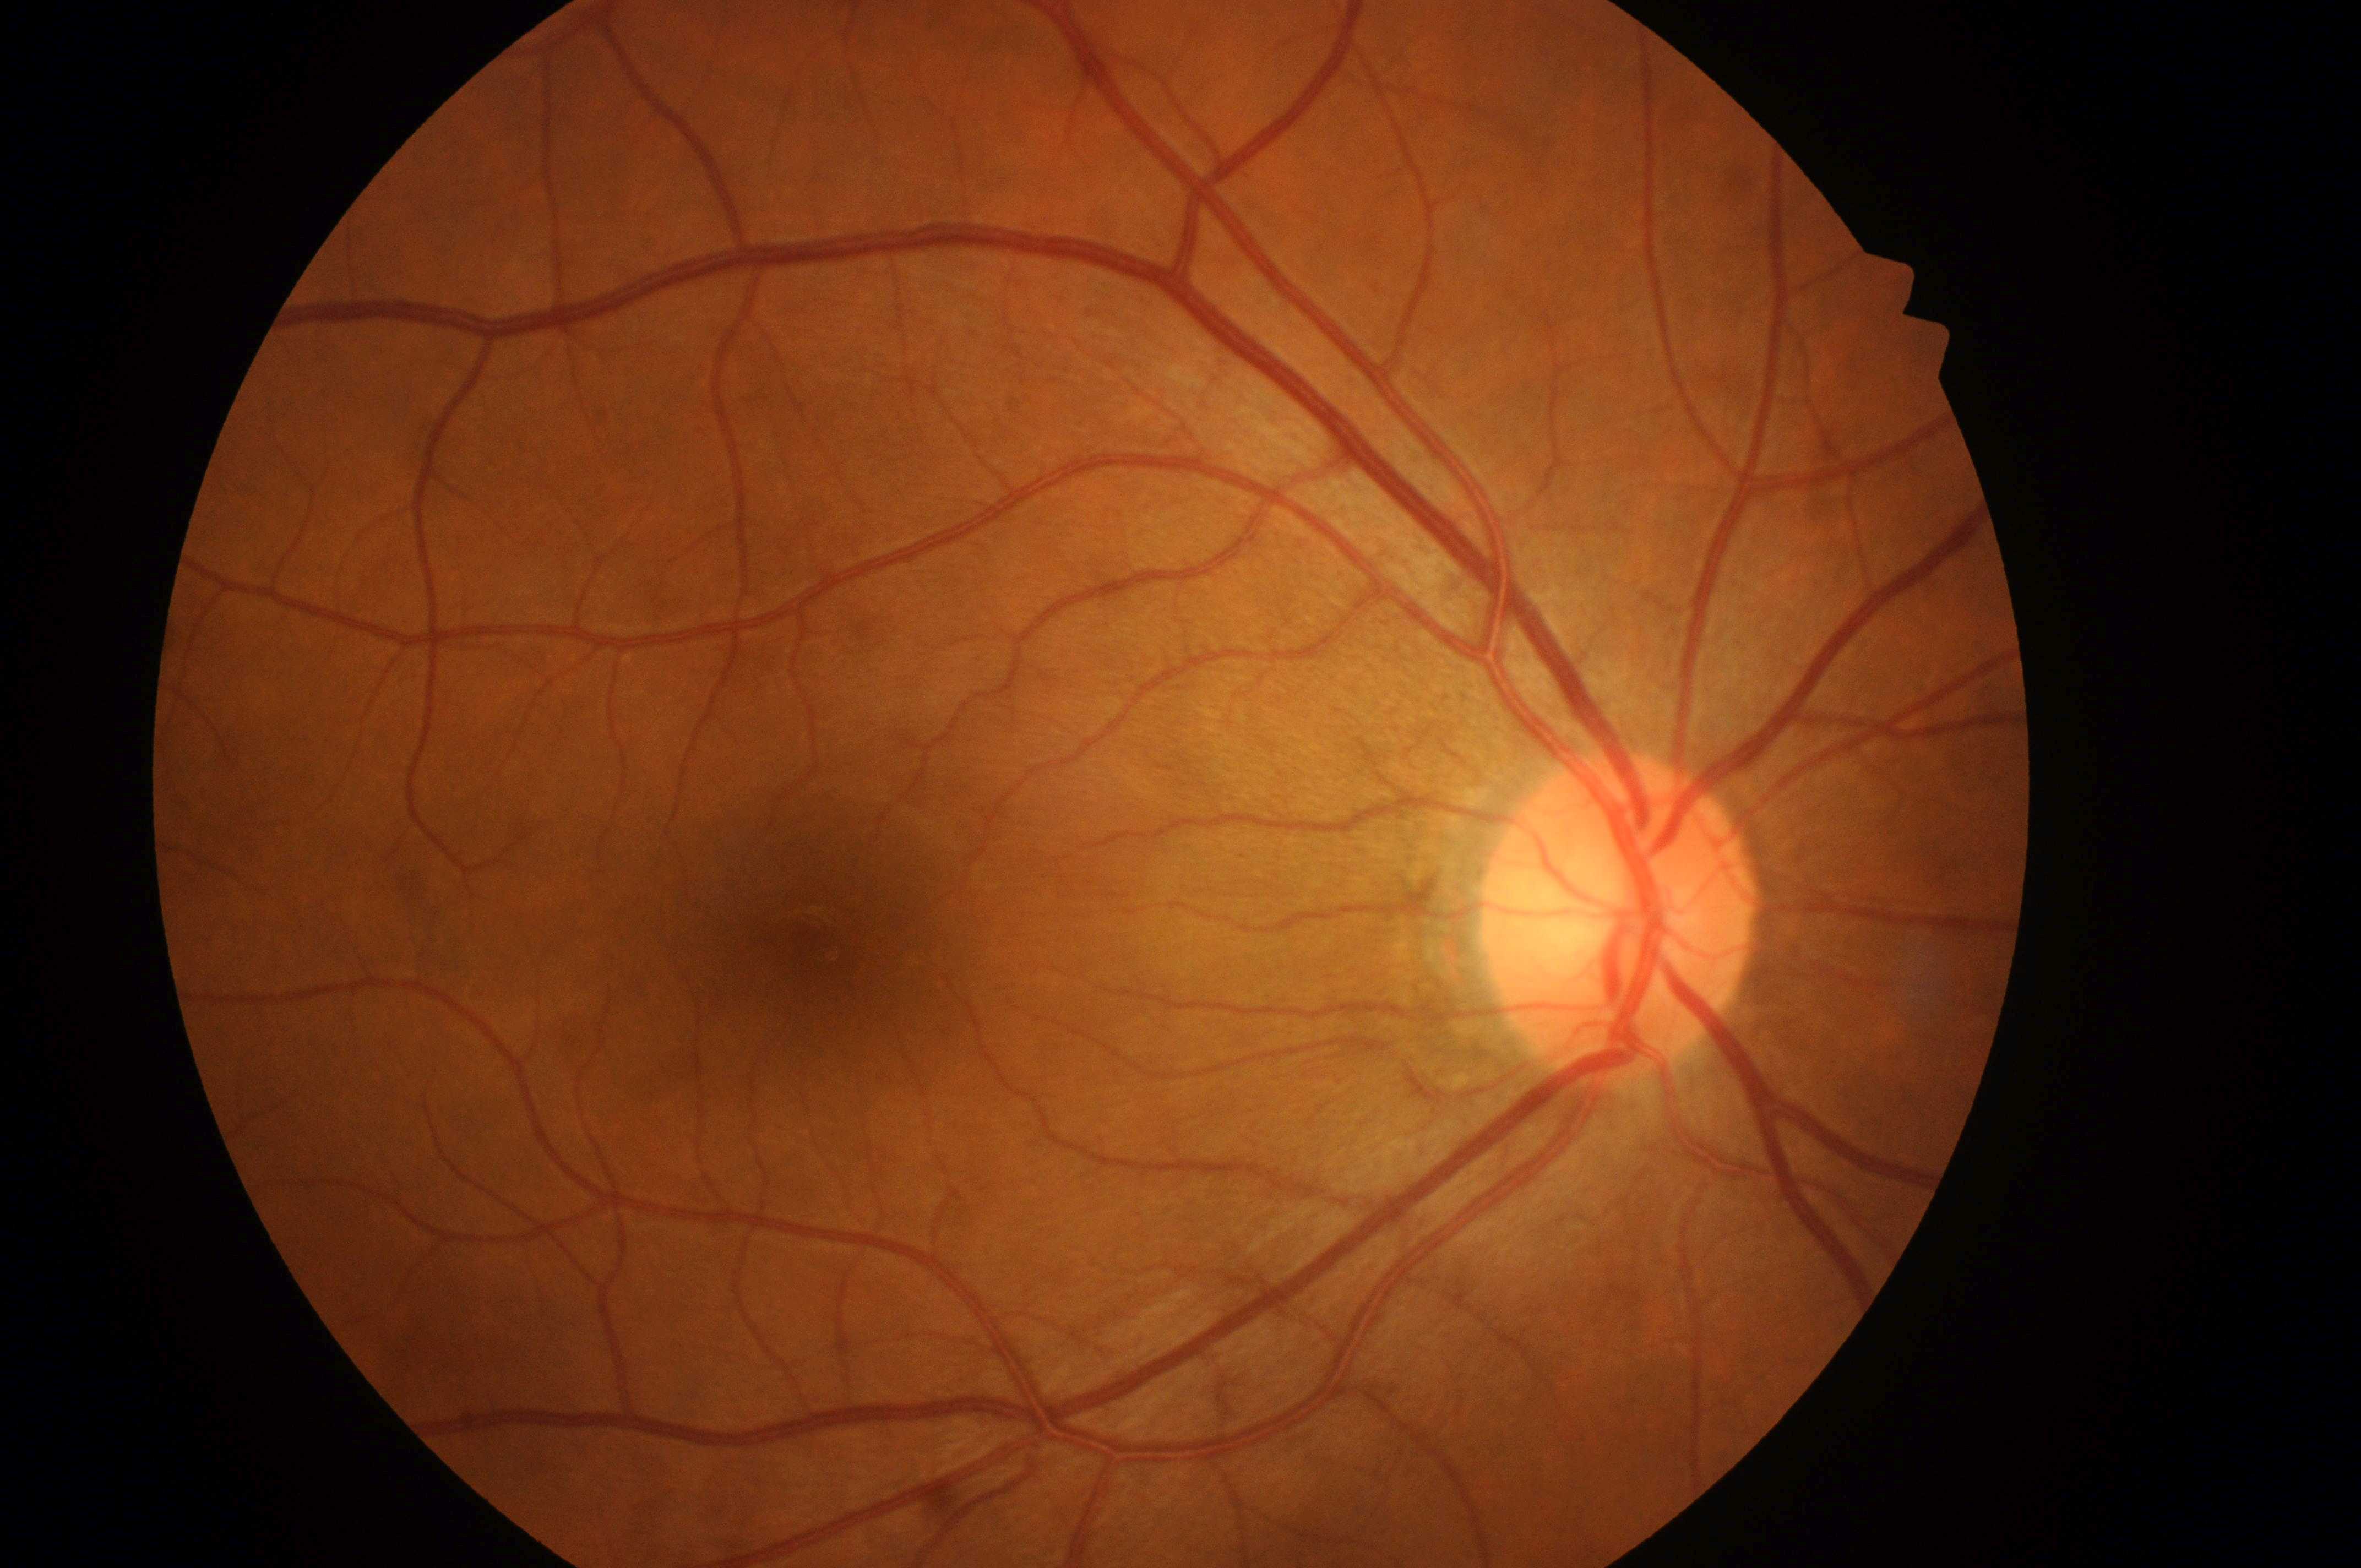 Imaged eye: right eye. DME is no risk (grade 0). DR: no apparent retinopathy (grade 0). Optic disc located at (1611,930). Macular center located at (821,952). No apparent diabetic retinopathy or macular edema.